NIDEK AFC-230 fundus camera:
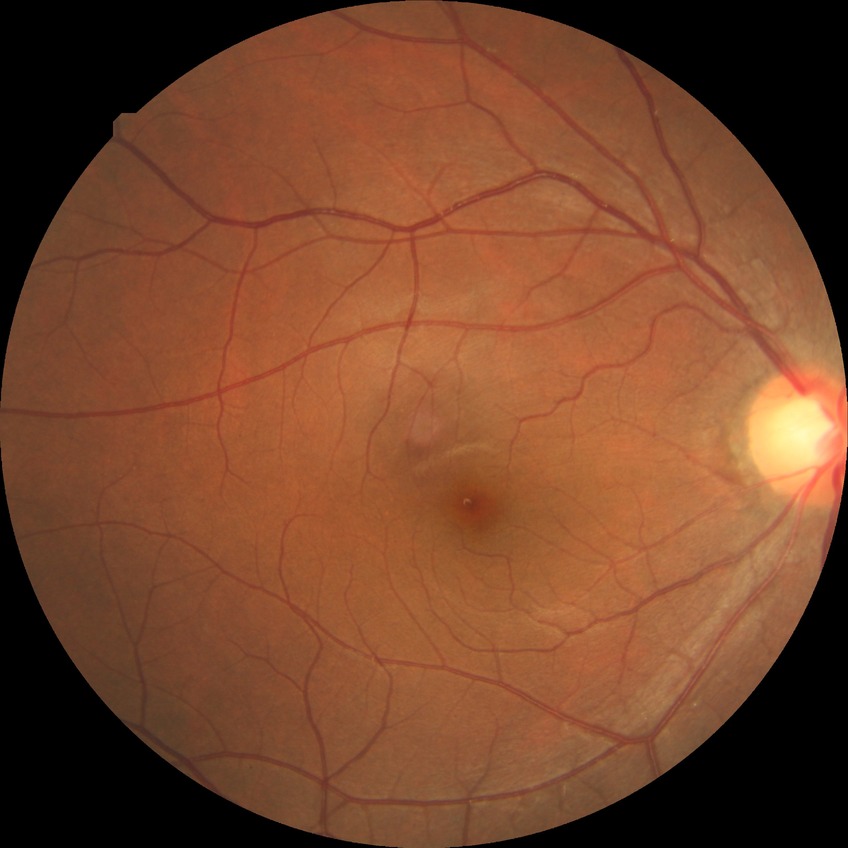 * diabetic retinopathy (DR) — NDR (no diabetic retinopathy)